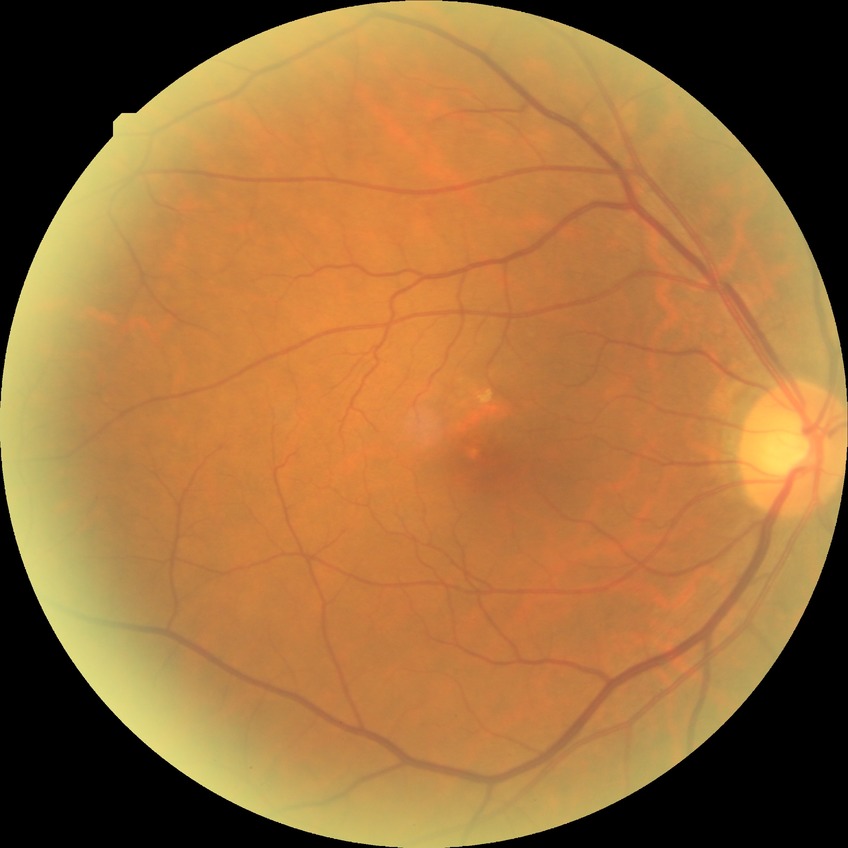

Davis DR grade is NDR.
No apparent diabetic retinopathy.